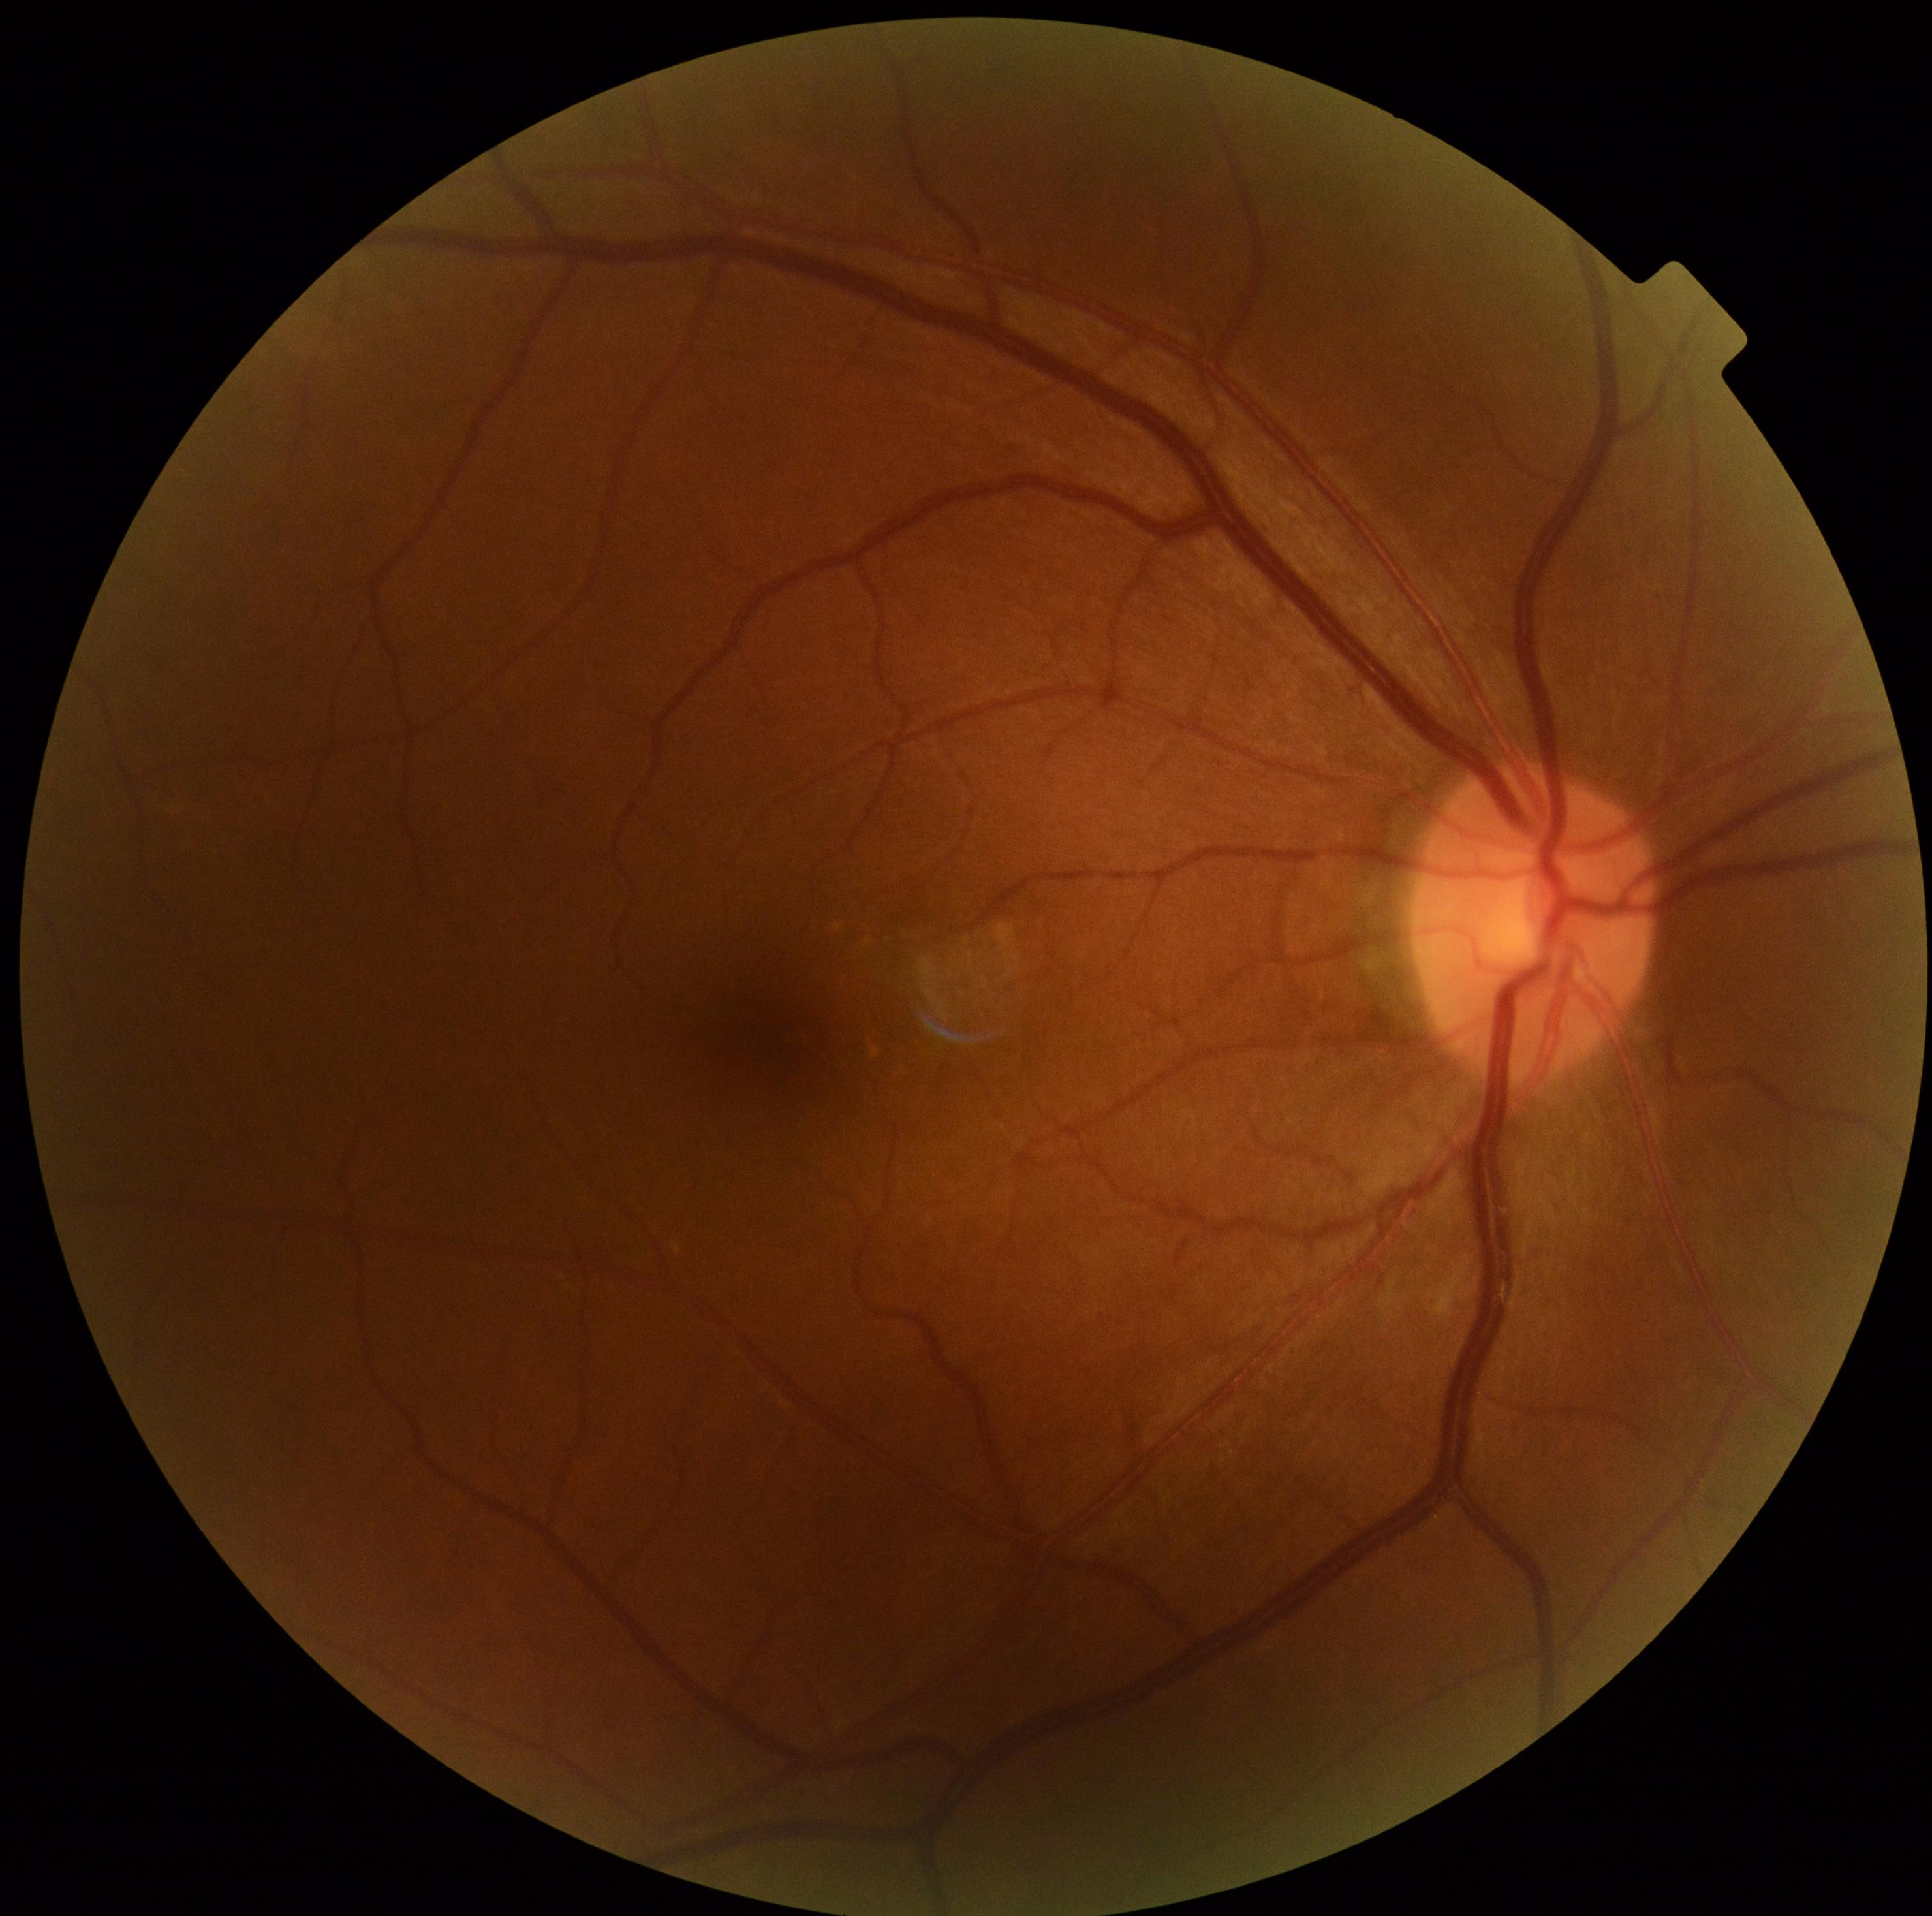 No diabetic retinal disease findings.
Diabetic retinopathy (DR): grade 0 (no apparent retinopathy).